Image size 1960x1897: 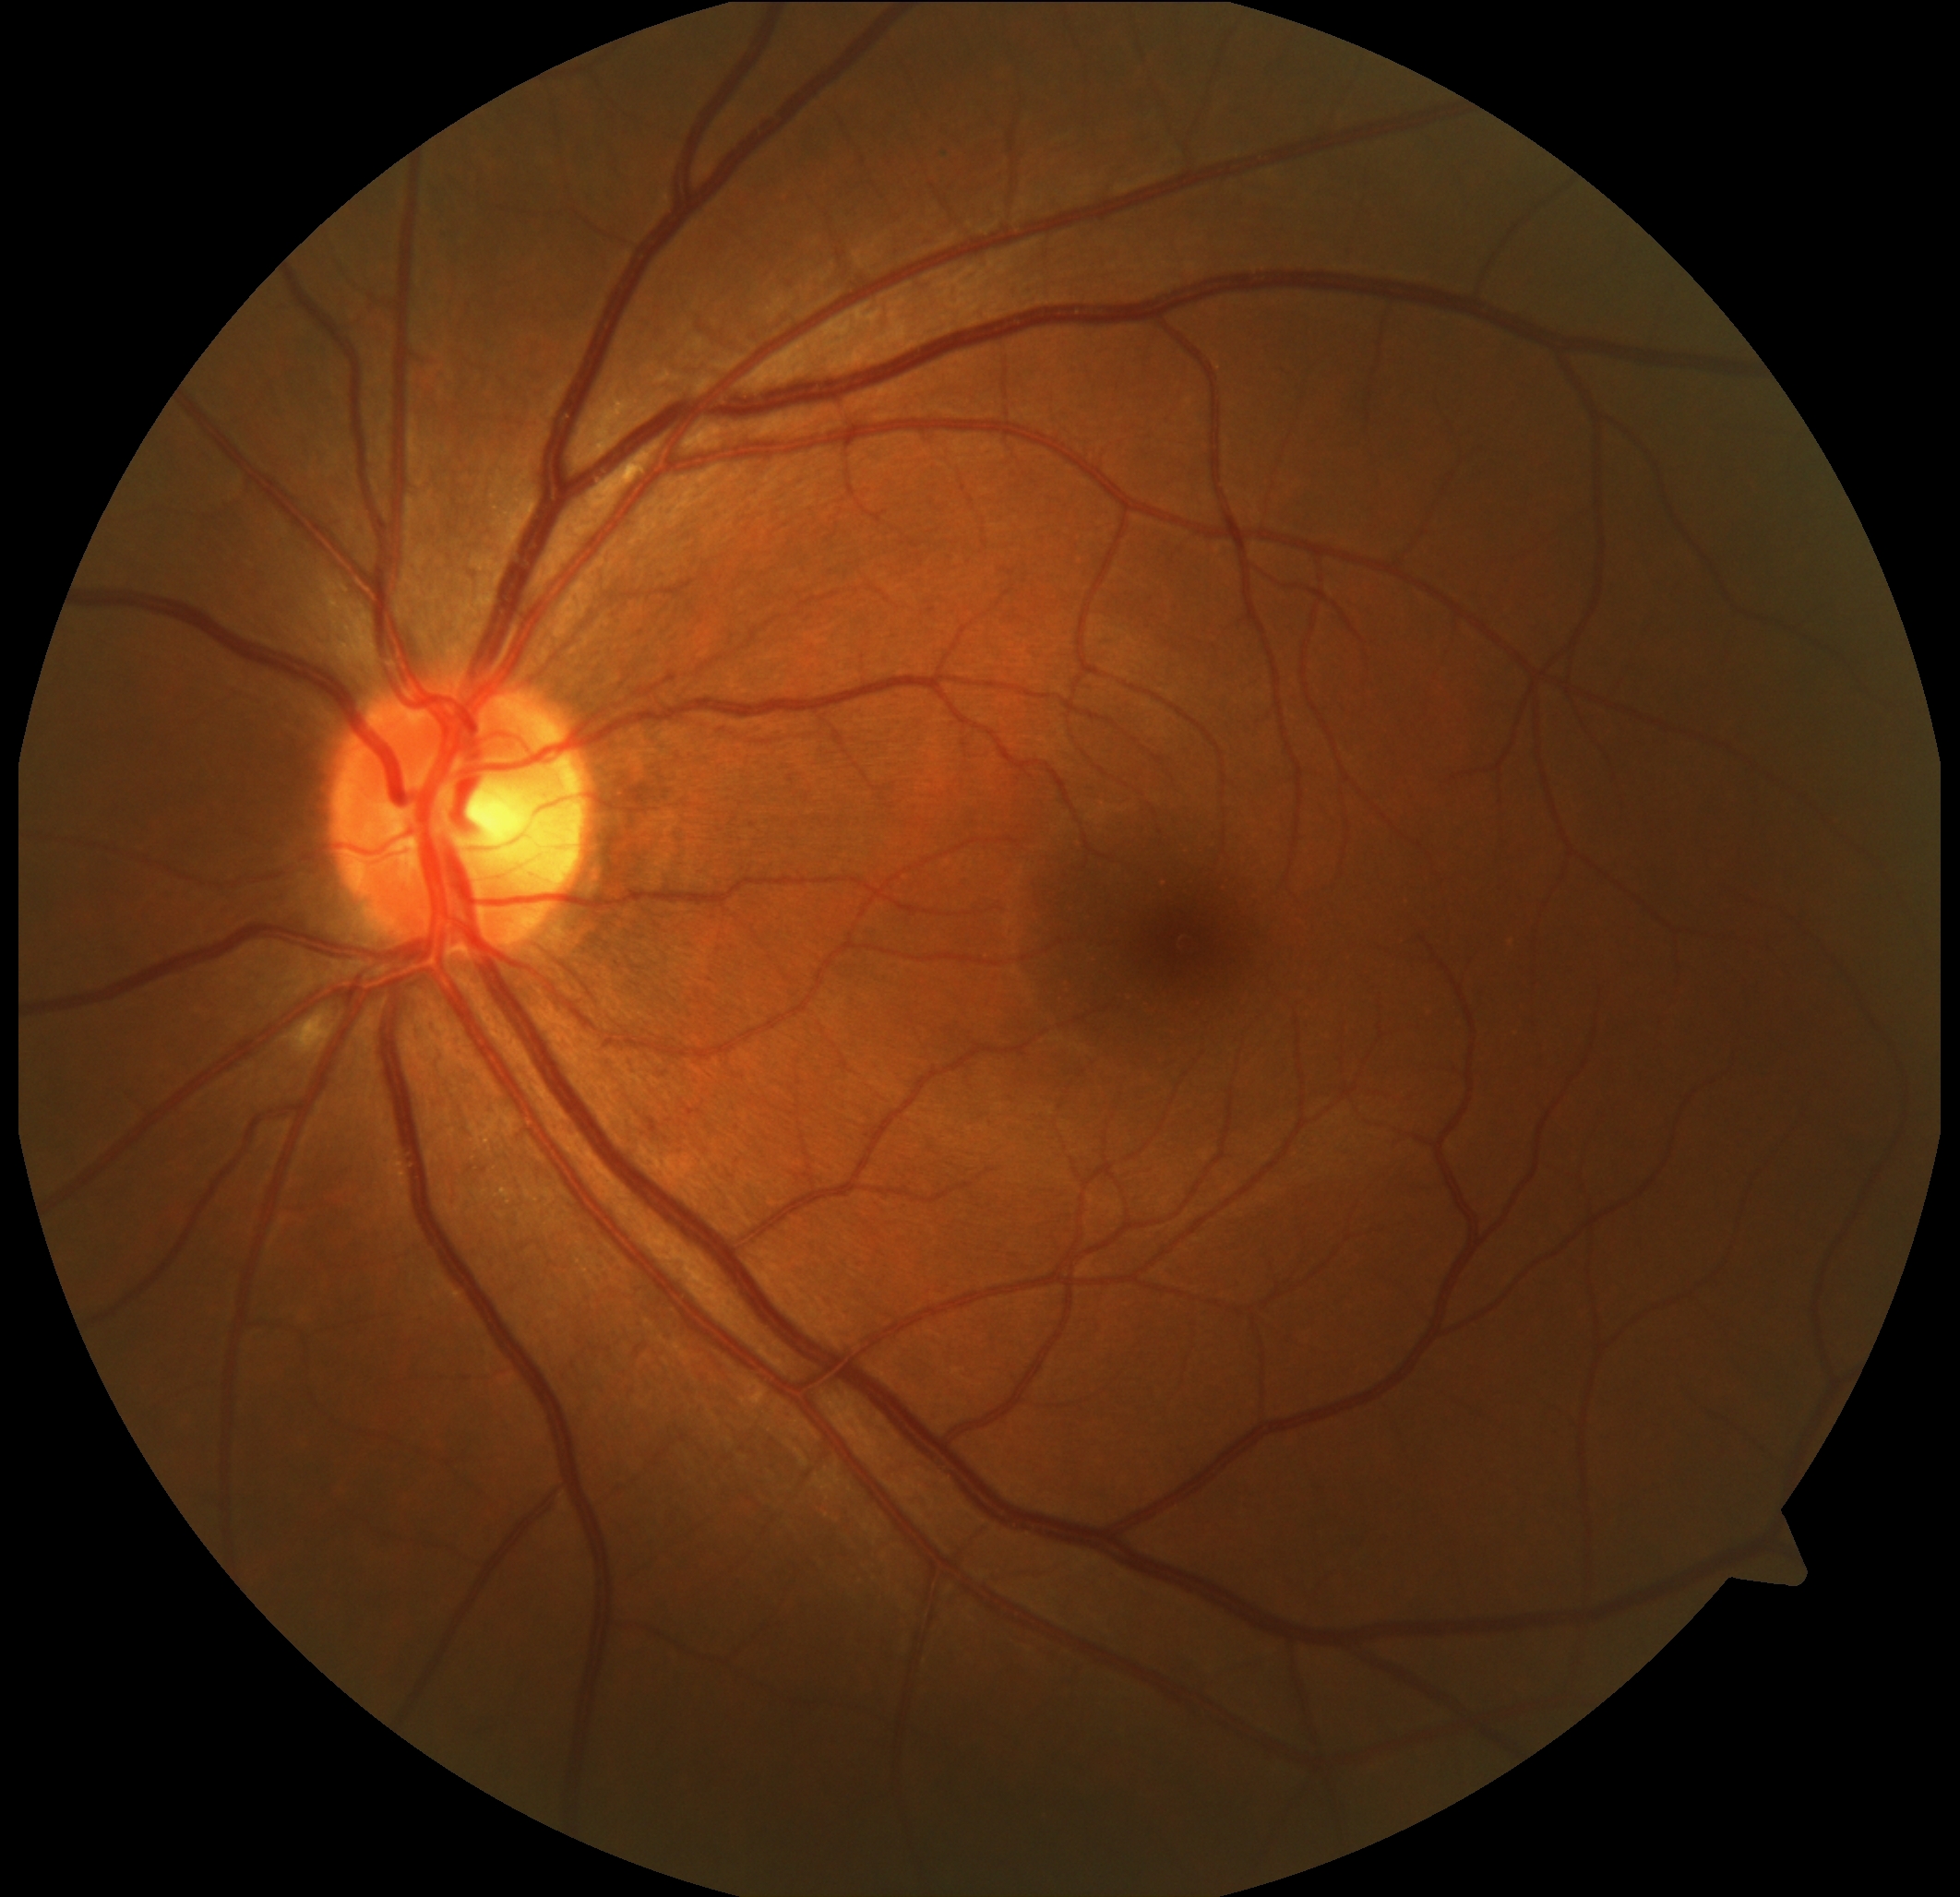
DR stage = moderate NPDR (grade 2), DR class = non-proliferative diabetic retinopathy.